Modified Davis classification
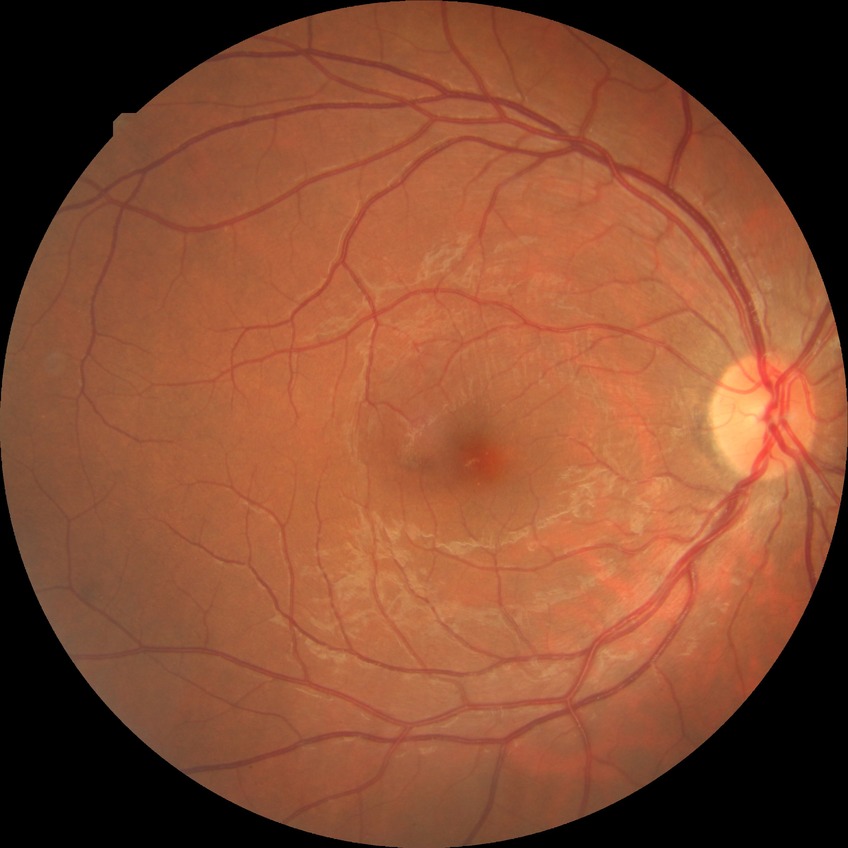
Retinopathy grade is no diabetic retinopathy.